Phoenix ICON wide-field infant fundus image. Camera: Phoenix ICON (100° FOV). 1240x1240px — 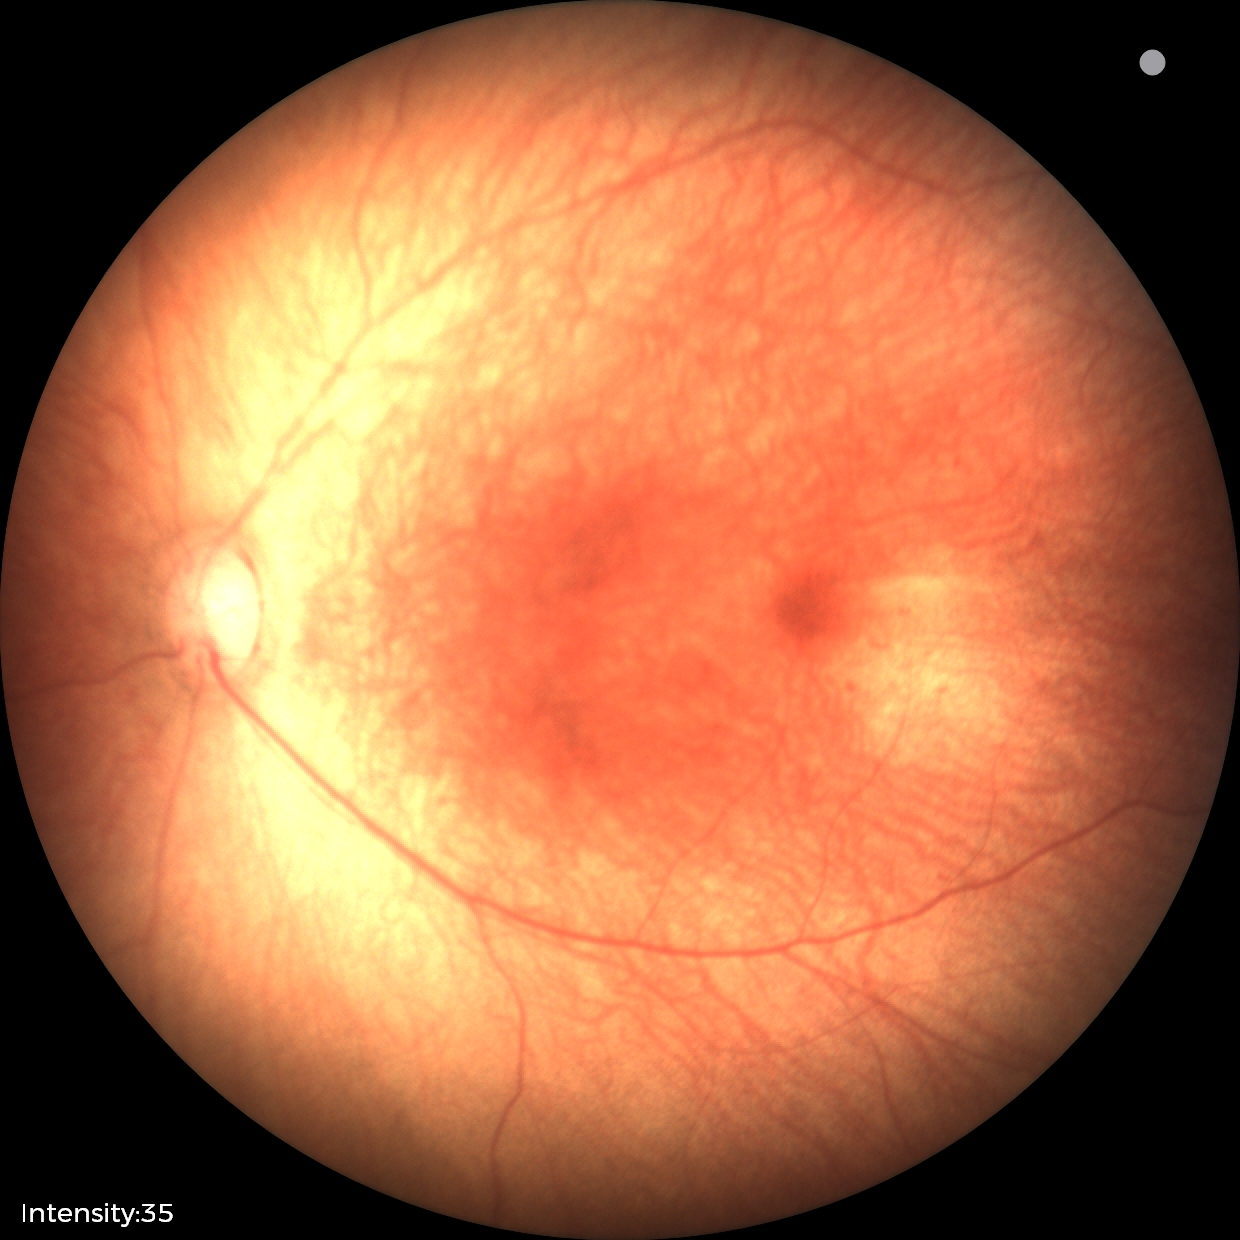 Diagnosis = normal retinal appearance